Color fundus photograph · image size 2184x1690 — 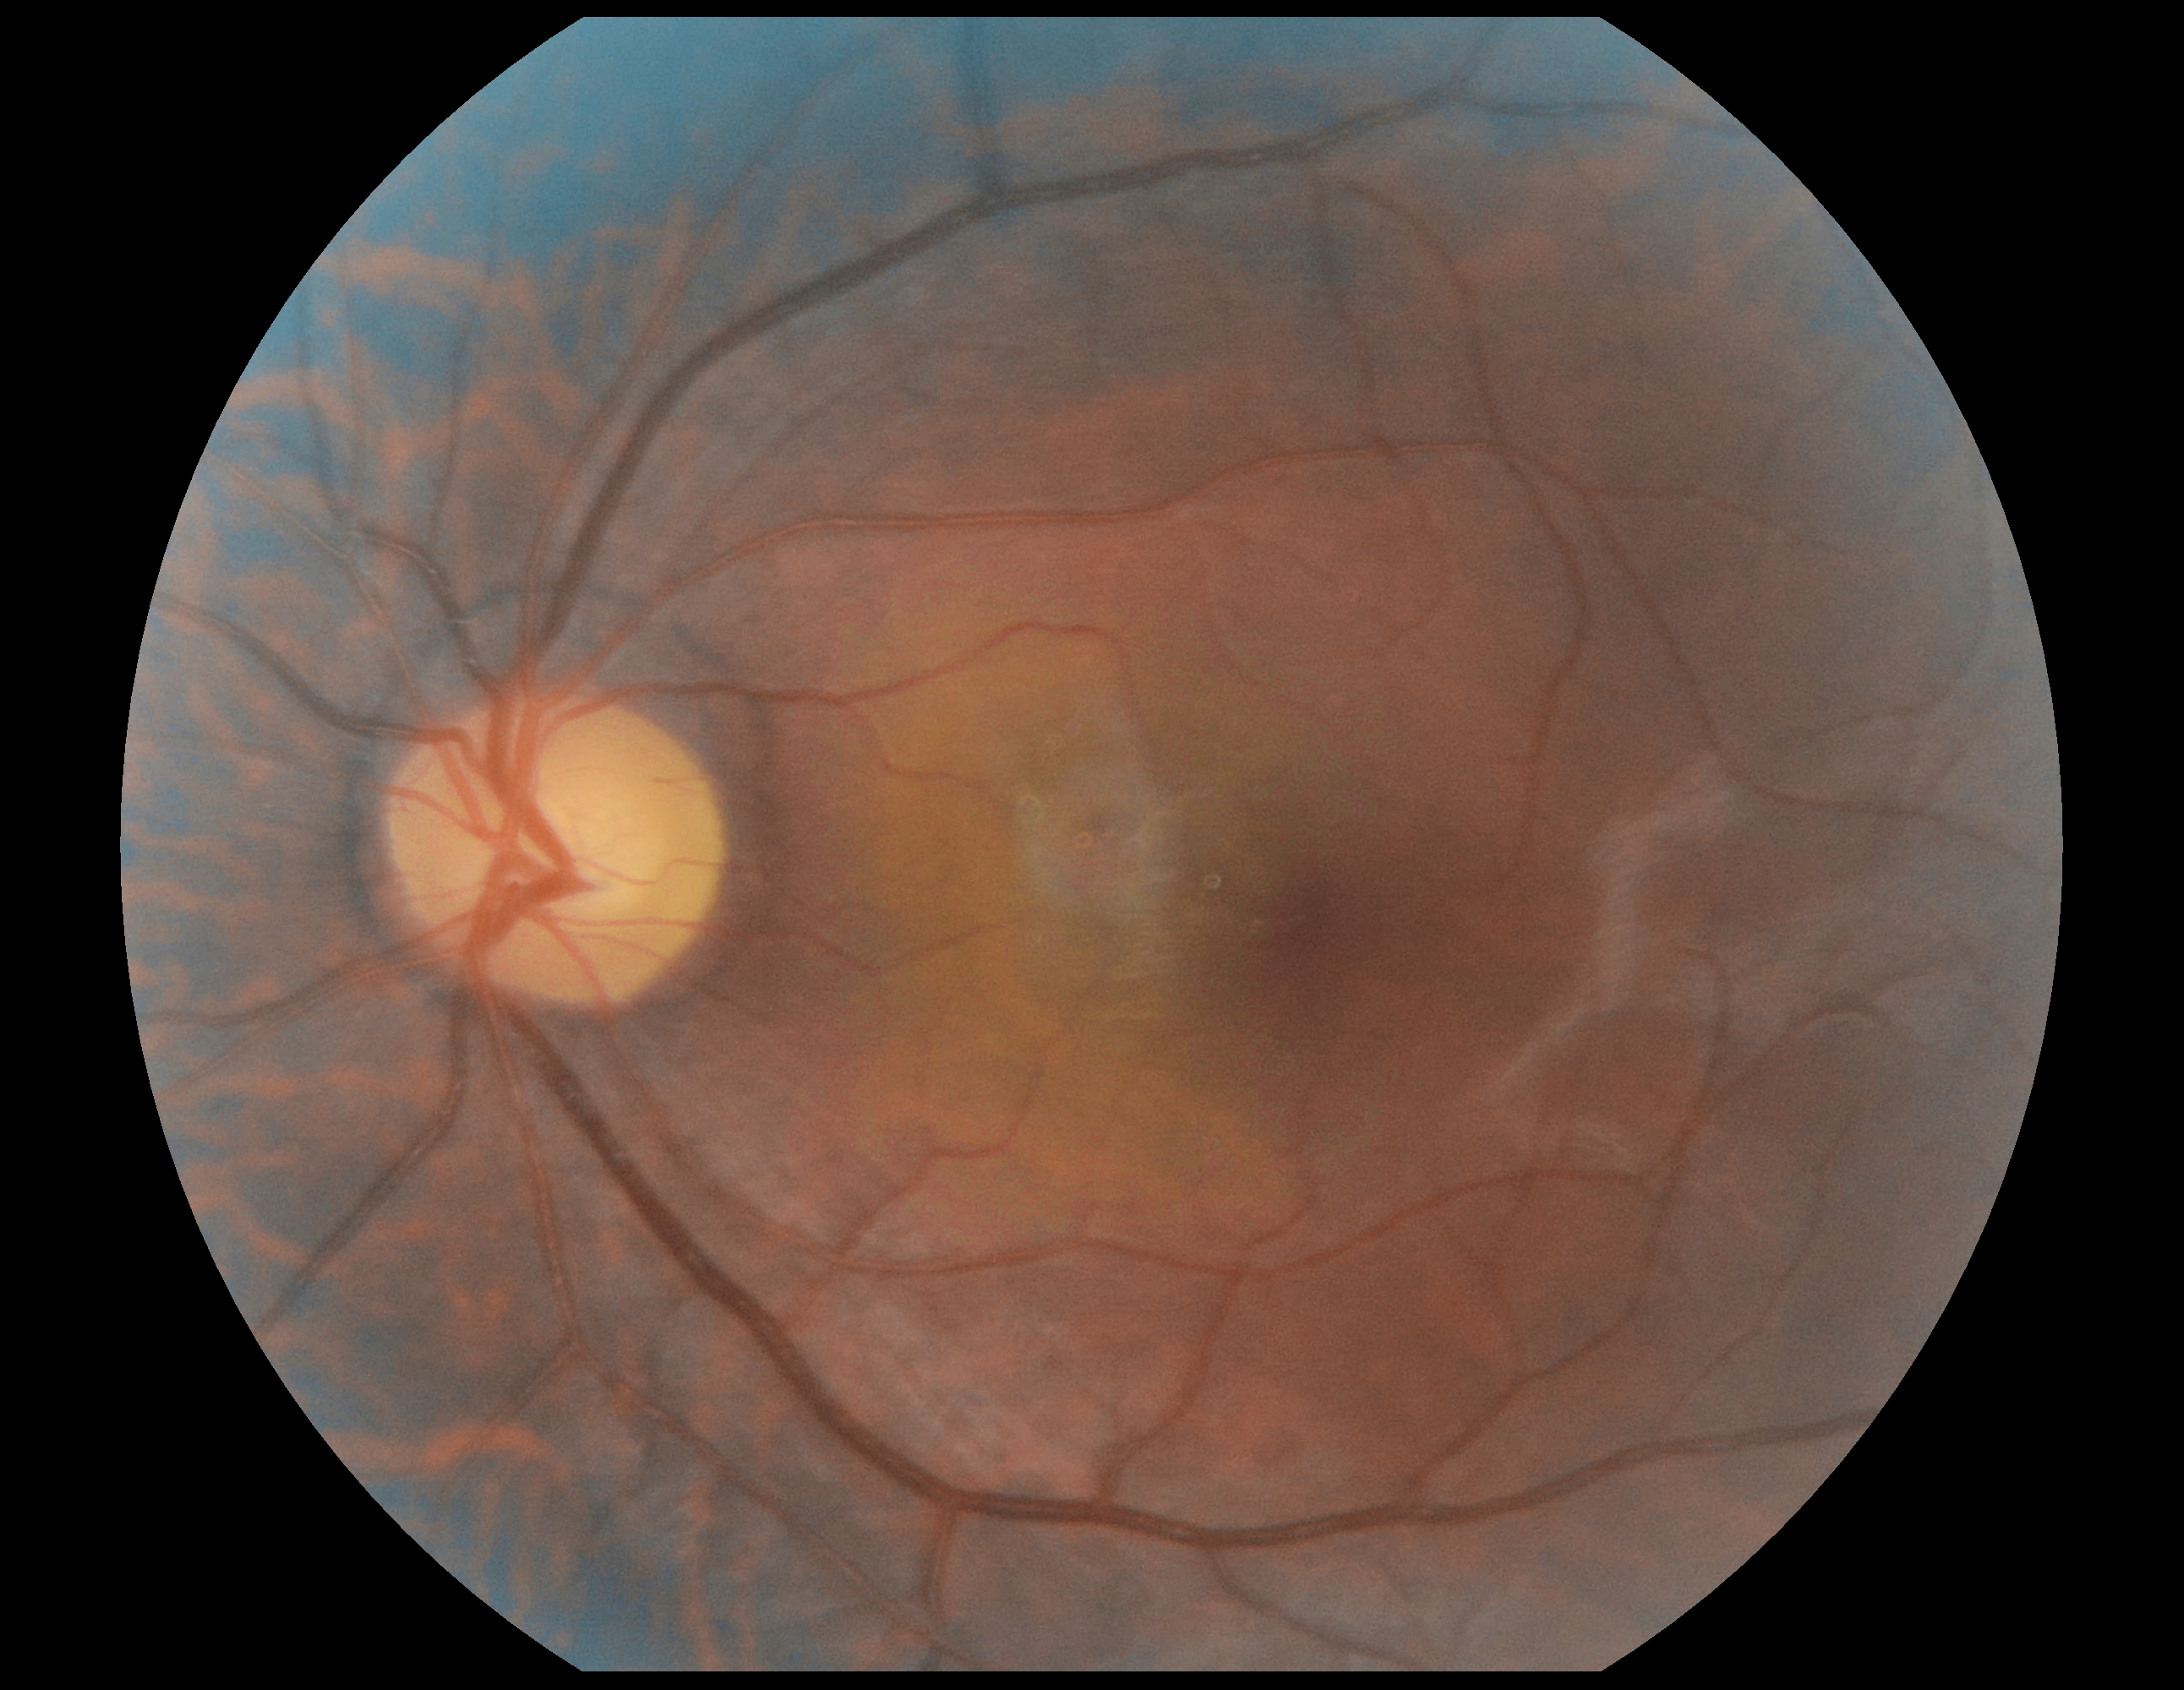 Retinopathy grade is 0.